NIDEK AFC-230 fundus camera. No pharmacologic dilation. FOV: 45 degrees. Image size 848x848:
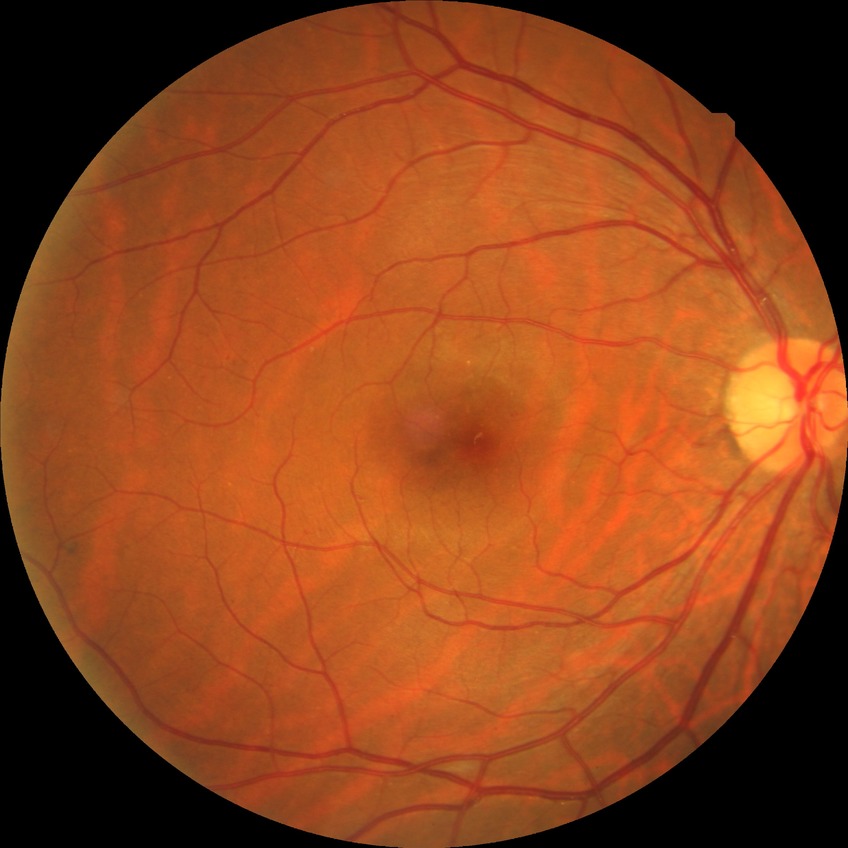
Diabetic retinopathy severity: simple diabetic retinopathy.